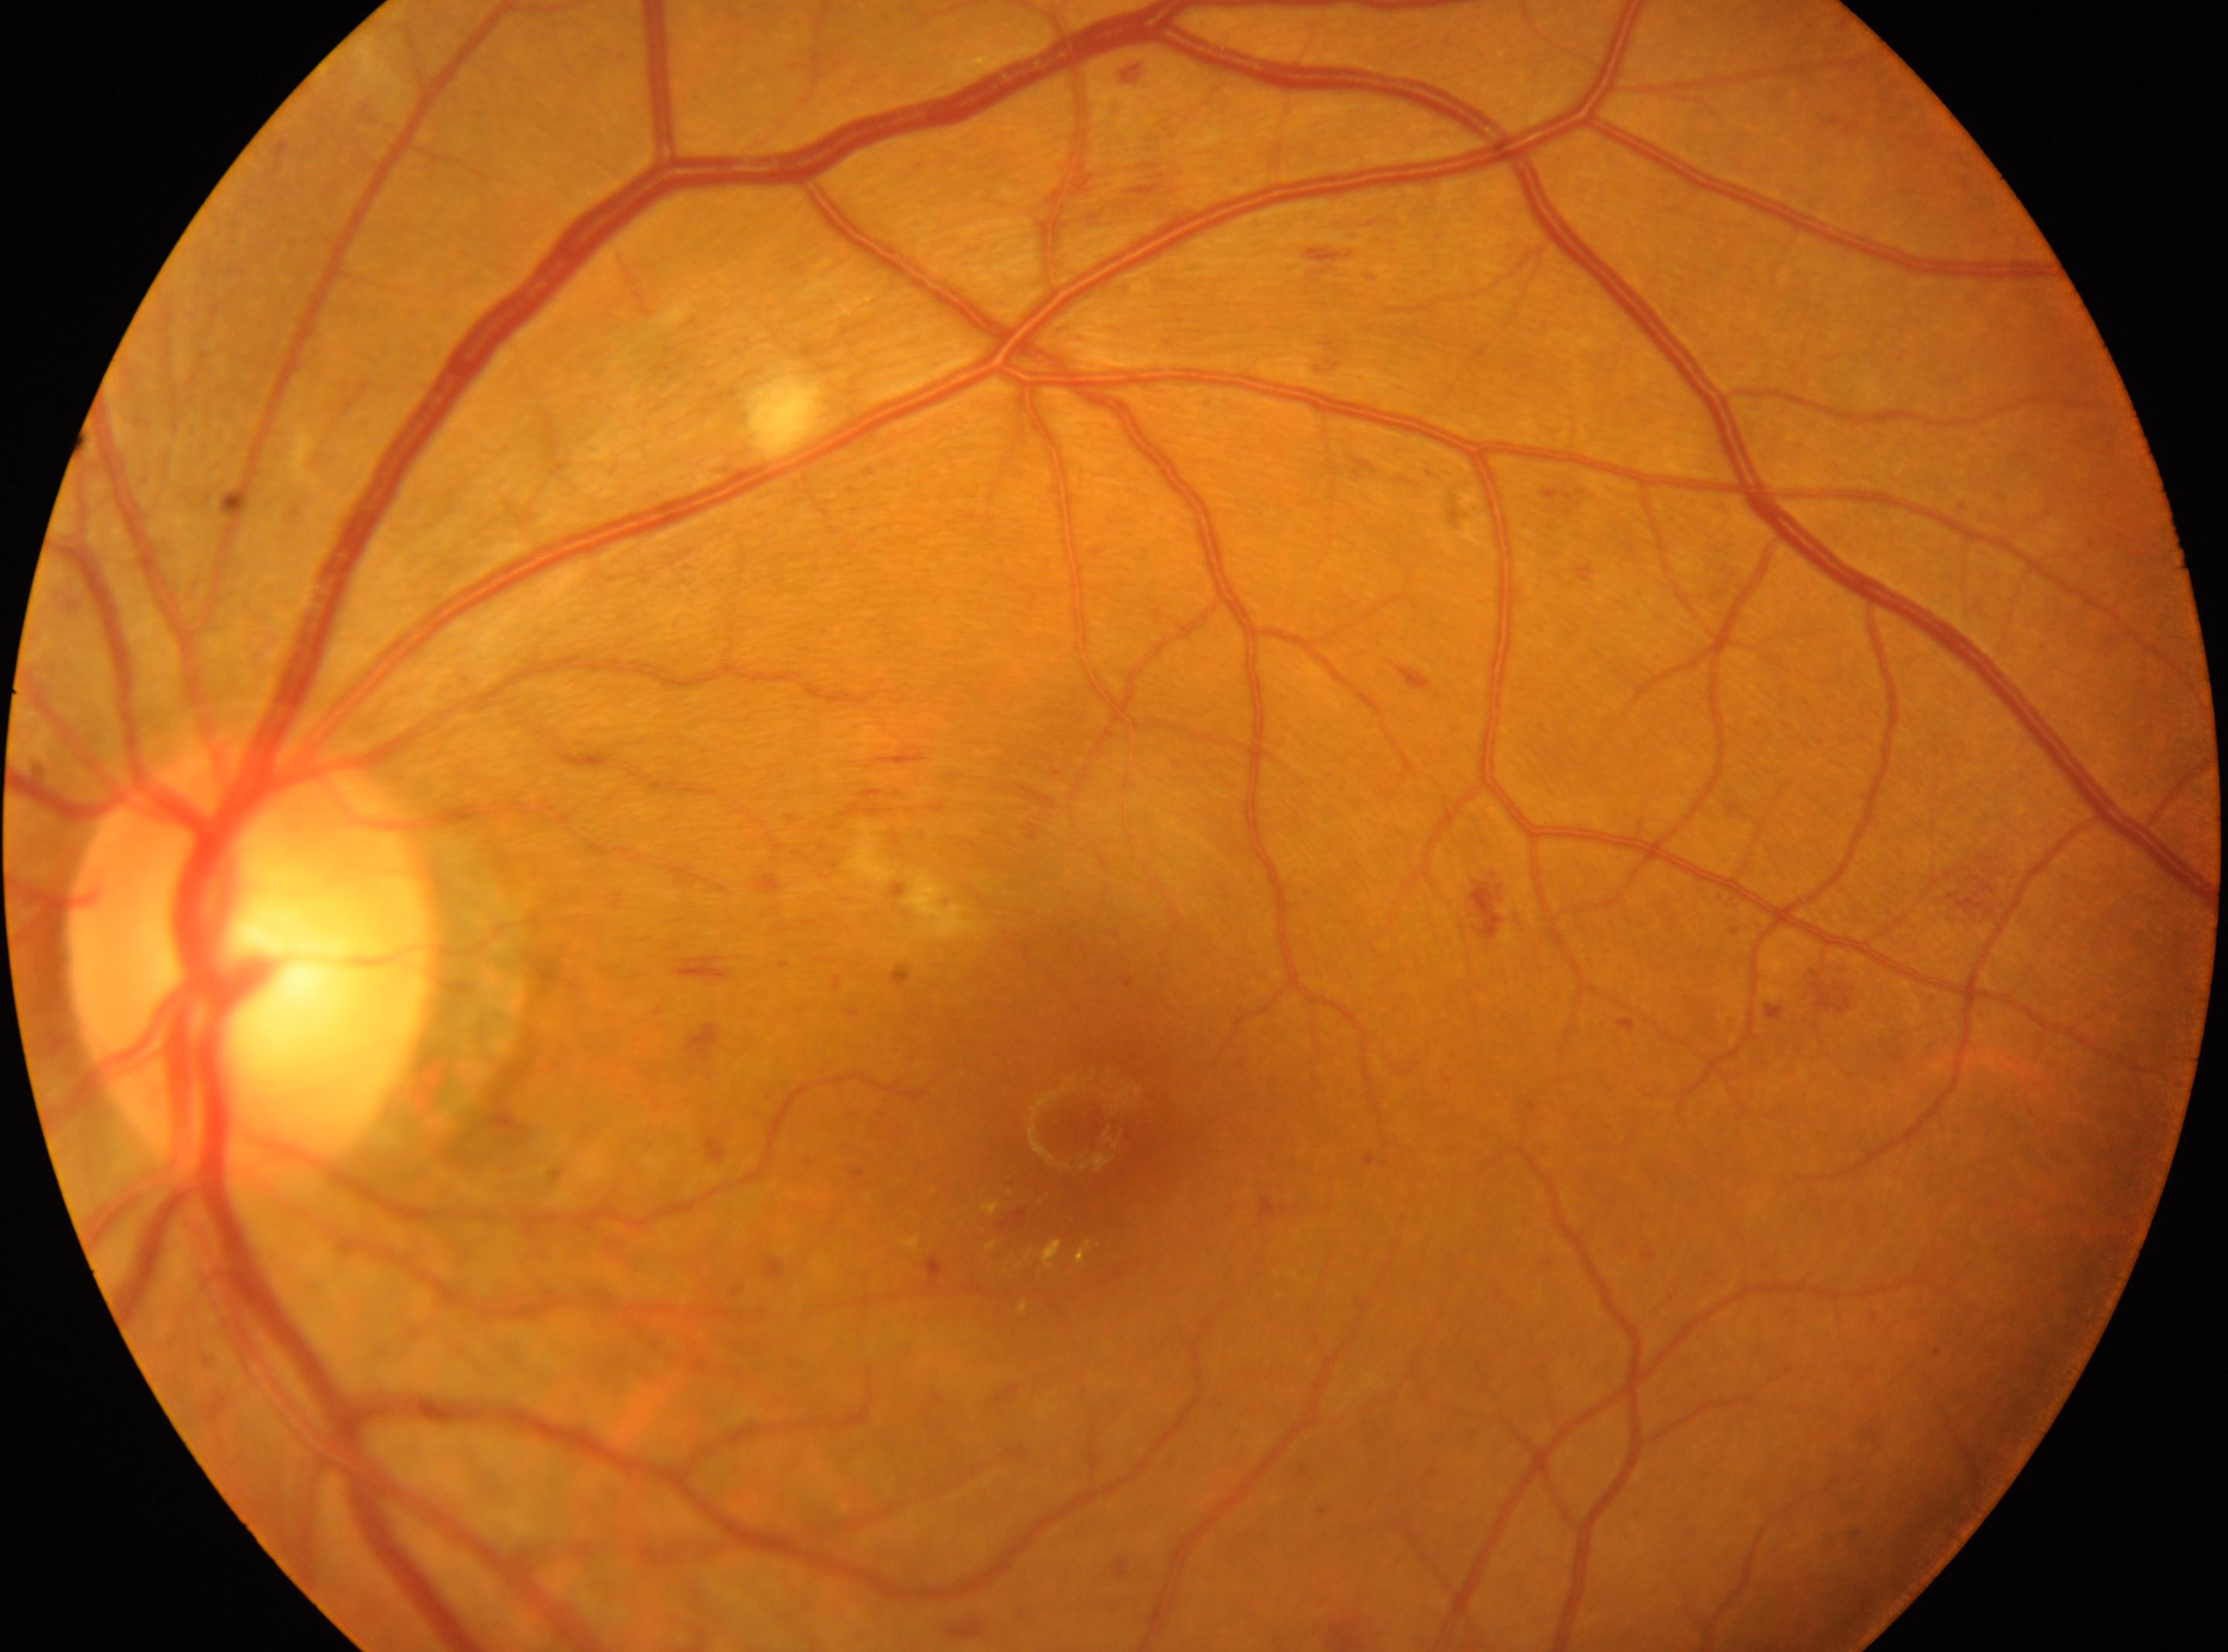

Fovea center: (1069,1125).
DR class: non-proliferative diabetic retinopathy.
The optic disc is at (246,963).
Retinopathy: grade 2 (moderate NPDR).
Eye: left.